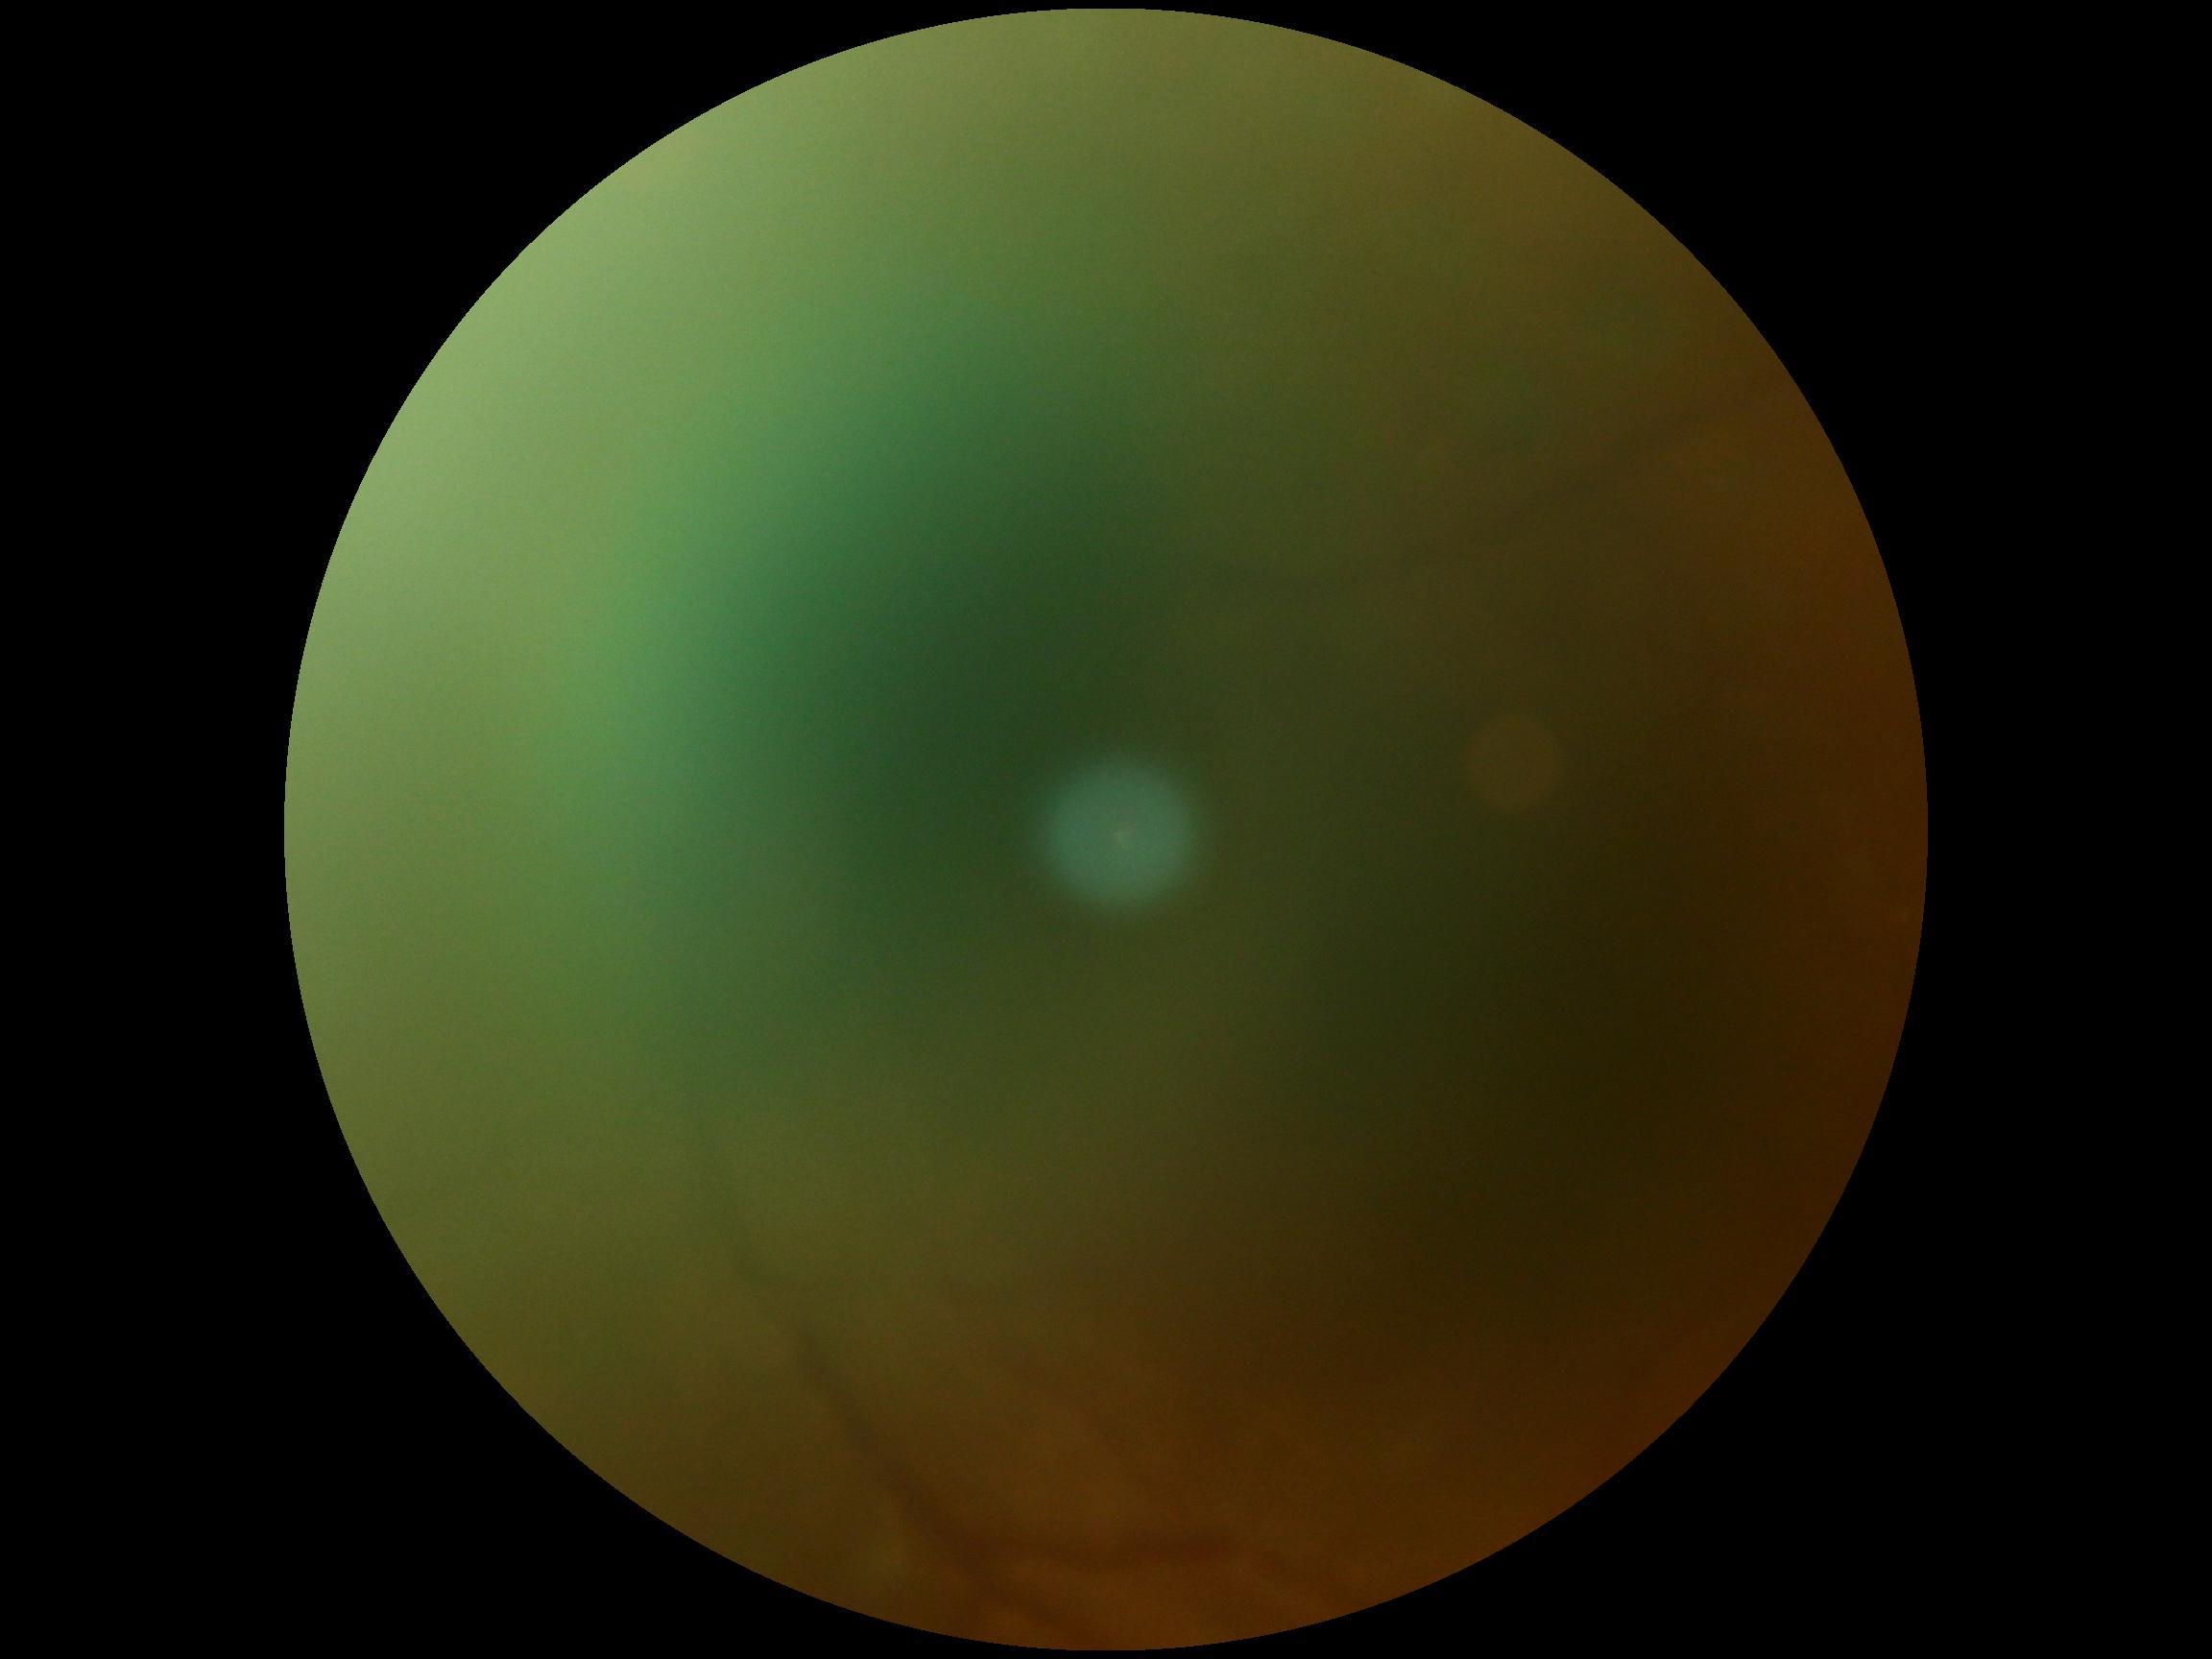 image quality=too poor for DR grading, DR=ungradable.